Color fundus photograph:
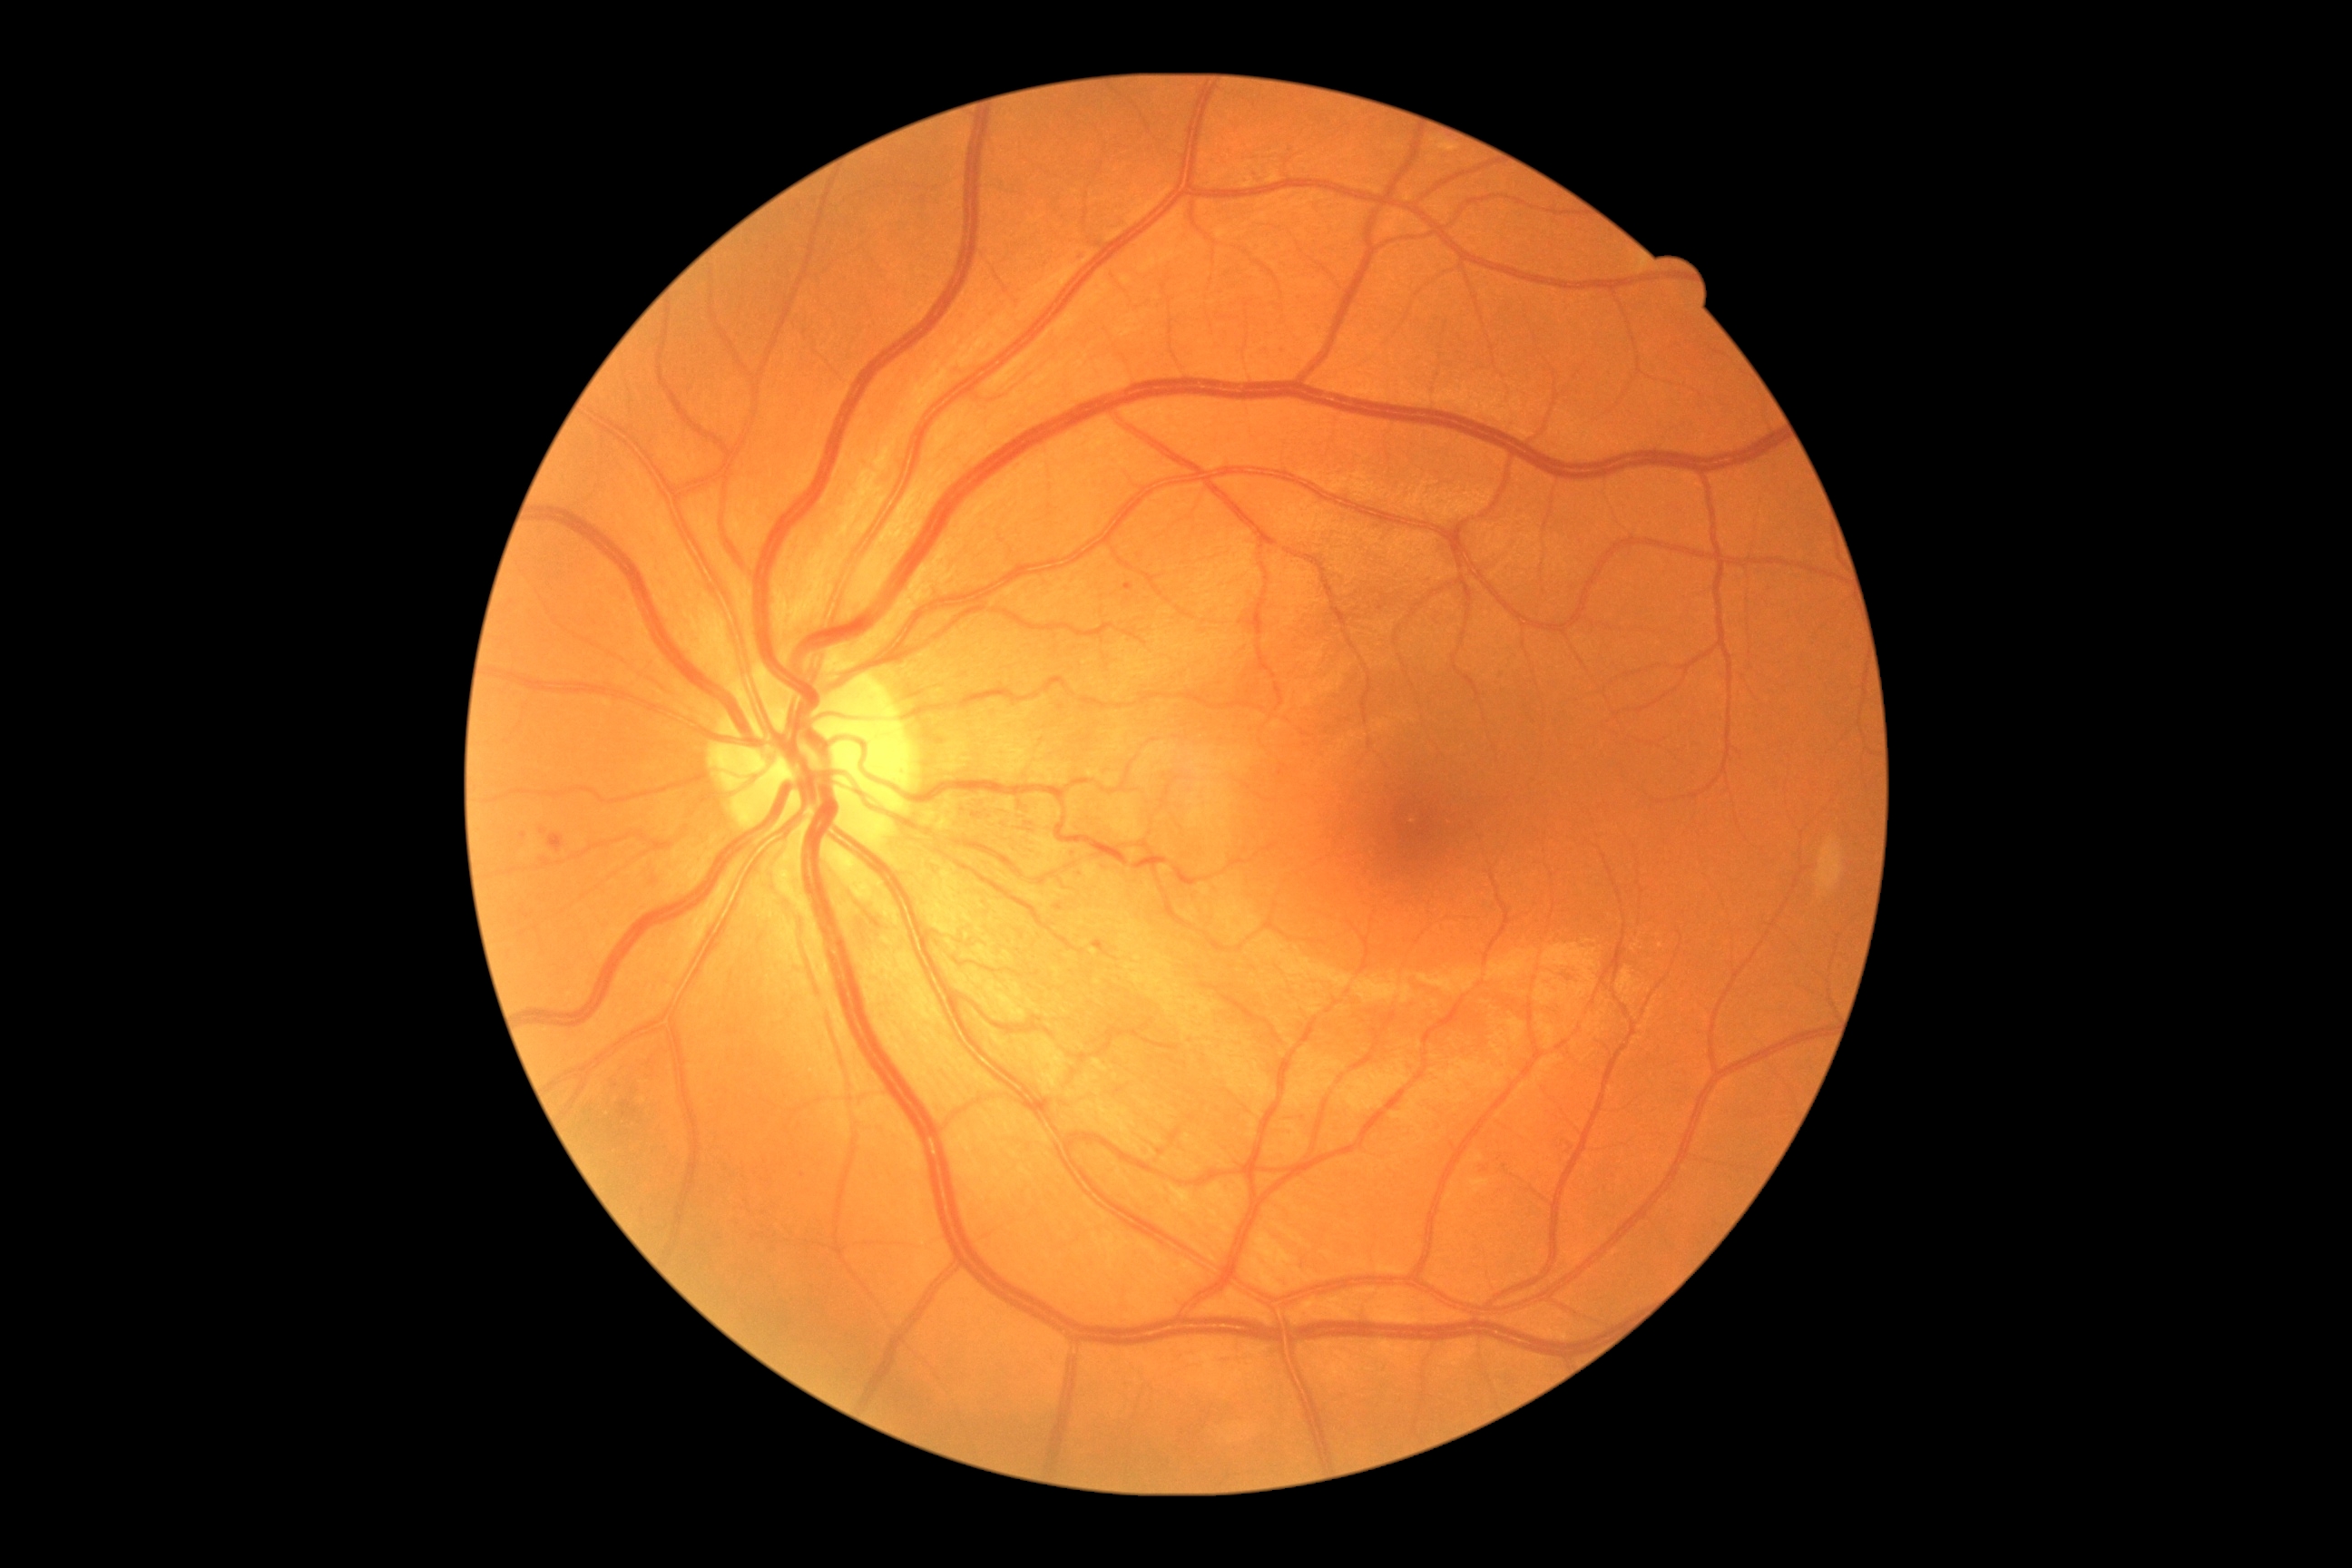
partial: true
dr_grade: 1
dr_grade_name: mild NPDR
lesions:
  se: []
  ma:
    - [left=1079, top=250, right=1088, bottom=257]
    - [left=540, top=828, right=547, bottom=836]
    - [left=553, top=836, right=564, bottom=847]
    - [left=1124, top=583, right=1133, bottom=591]
  ma_small_approx:
    - {"x": 1098, "y": 942}
    - {"x": 524, "y": 836}
    - {"x": 1281, "y": 773}
    - {"x": 1075, "y": 852}
    - {"x": 1079, "y": 872}
  he: []
  ex: []